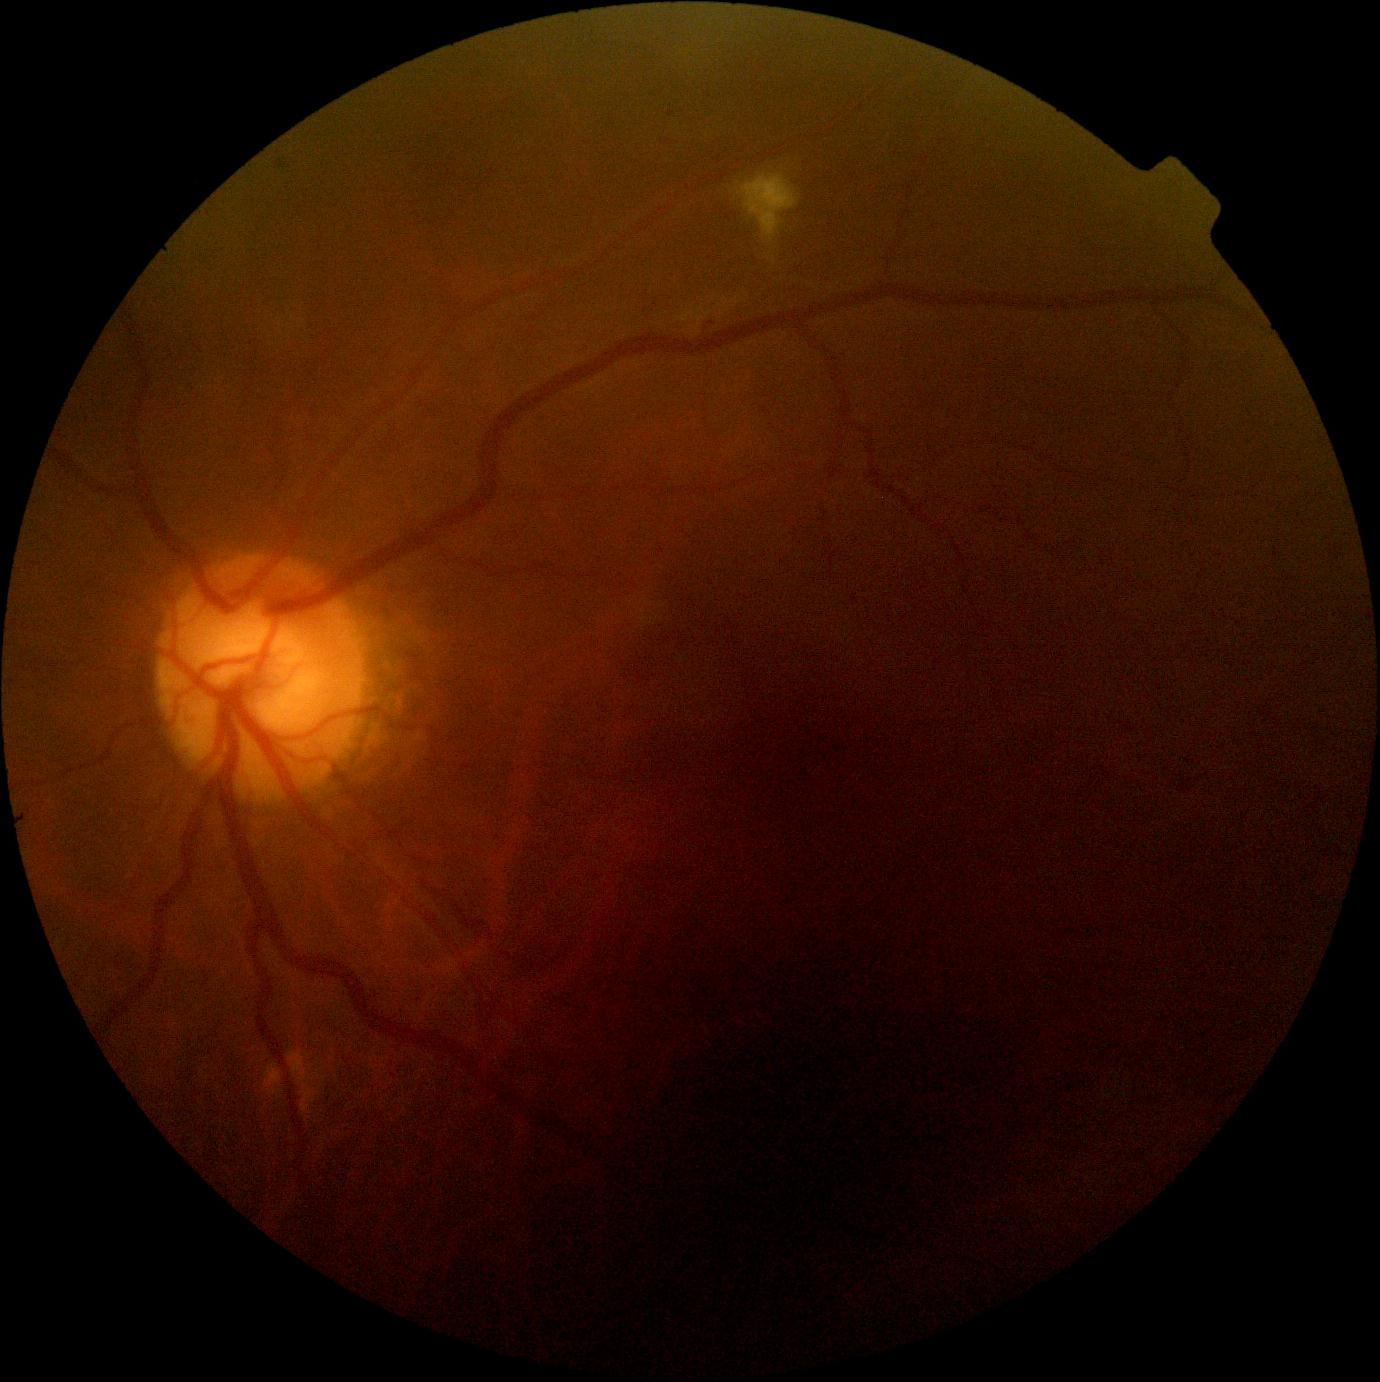
{
  "dr_grade": "grade 2"
}